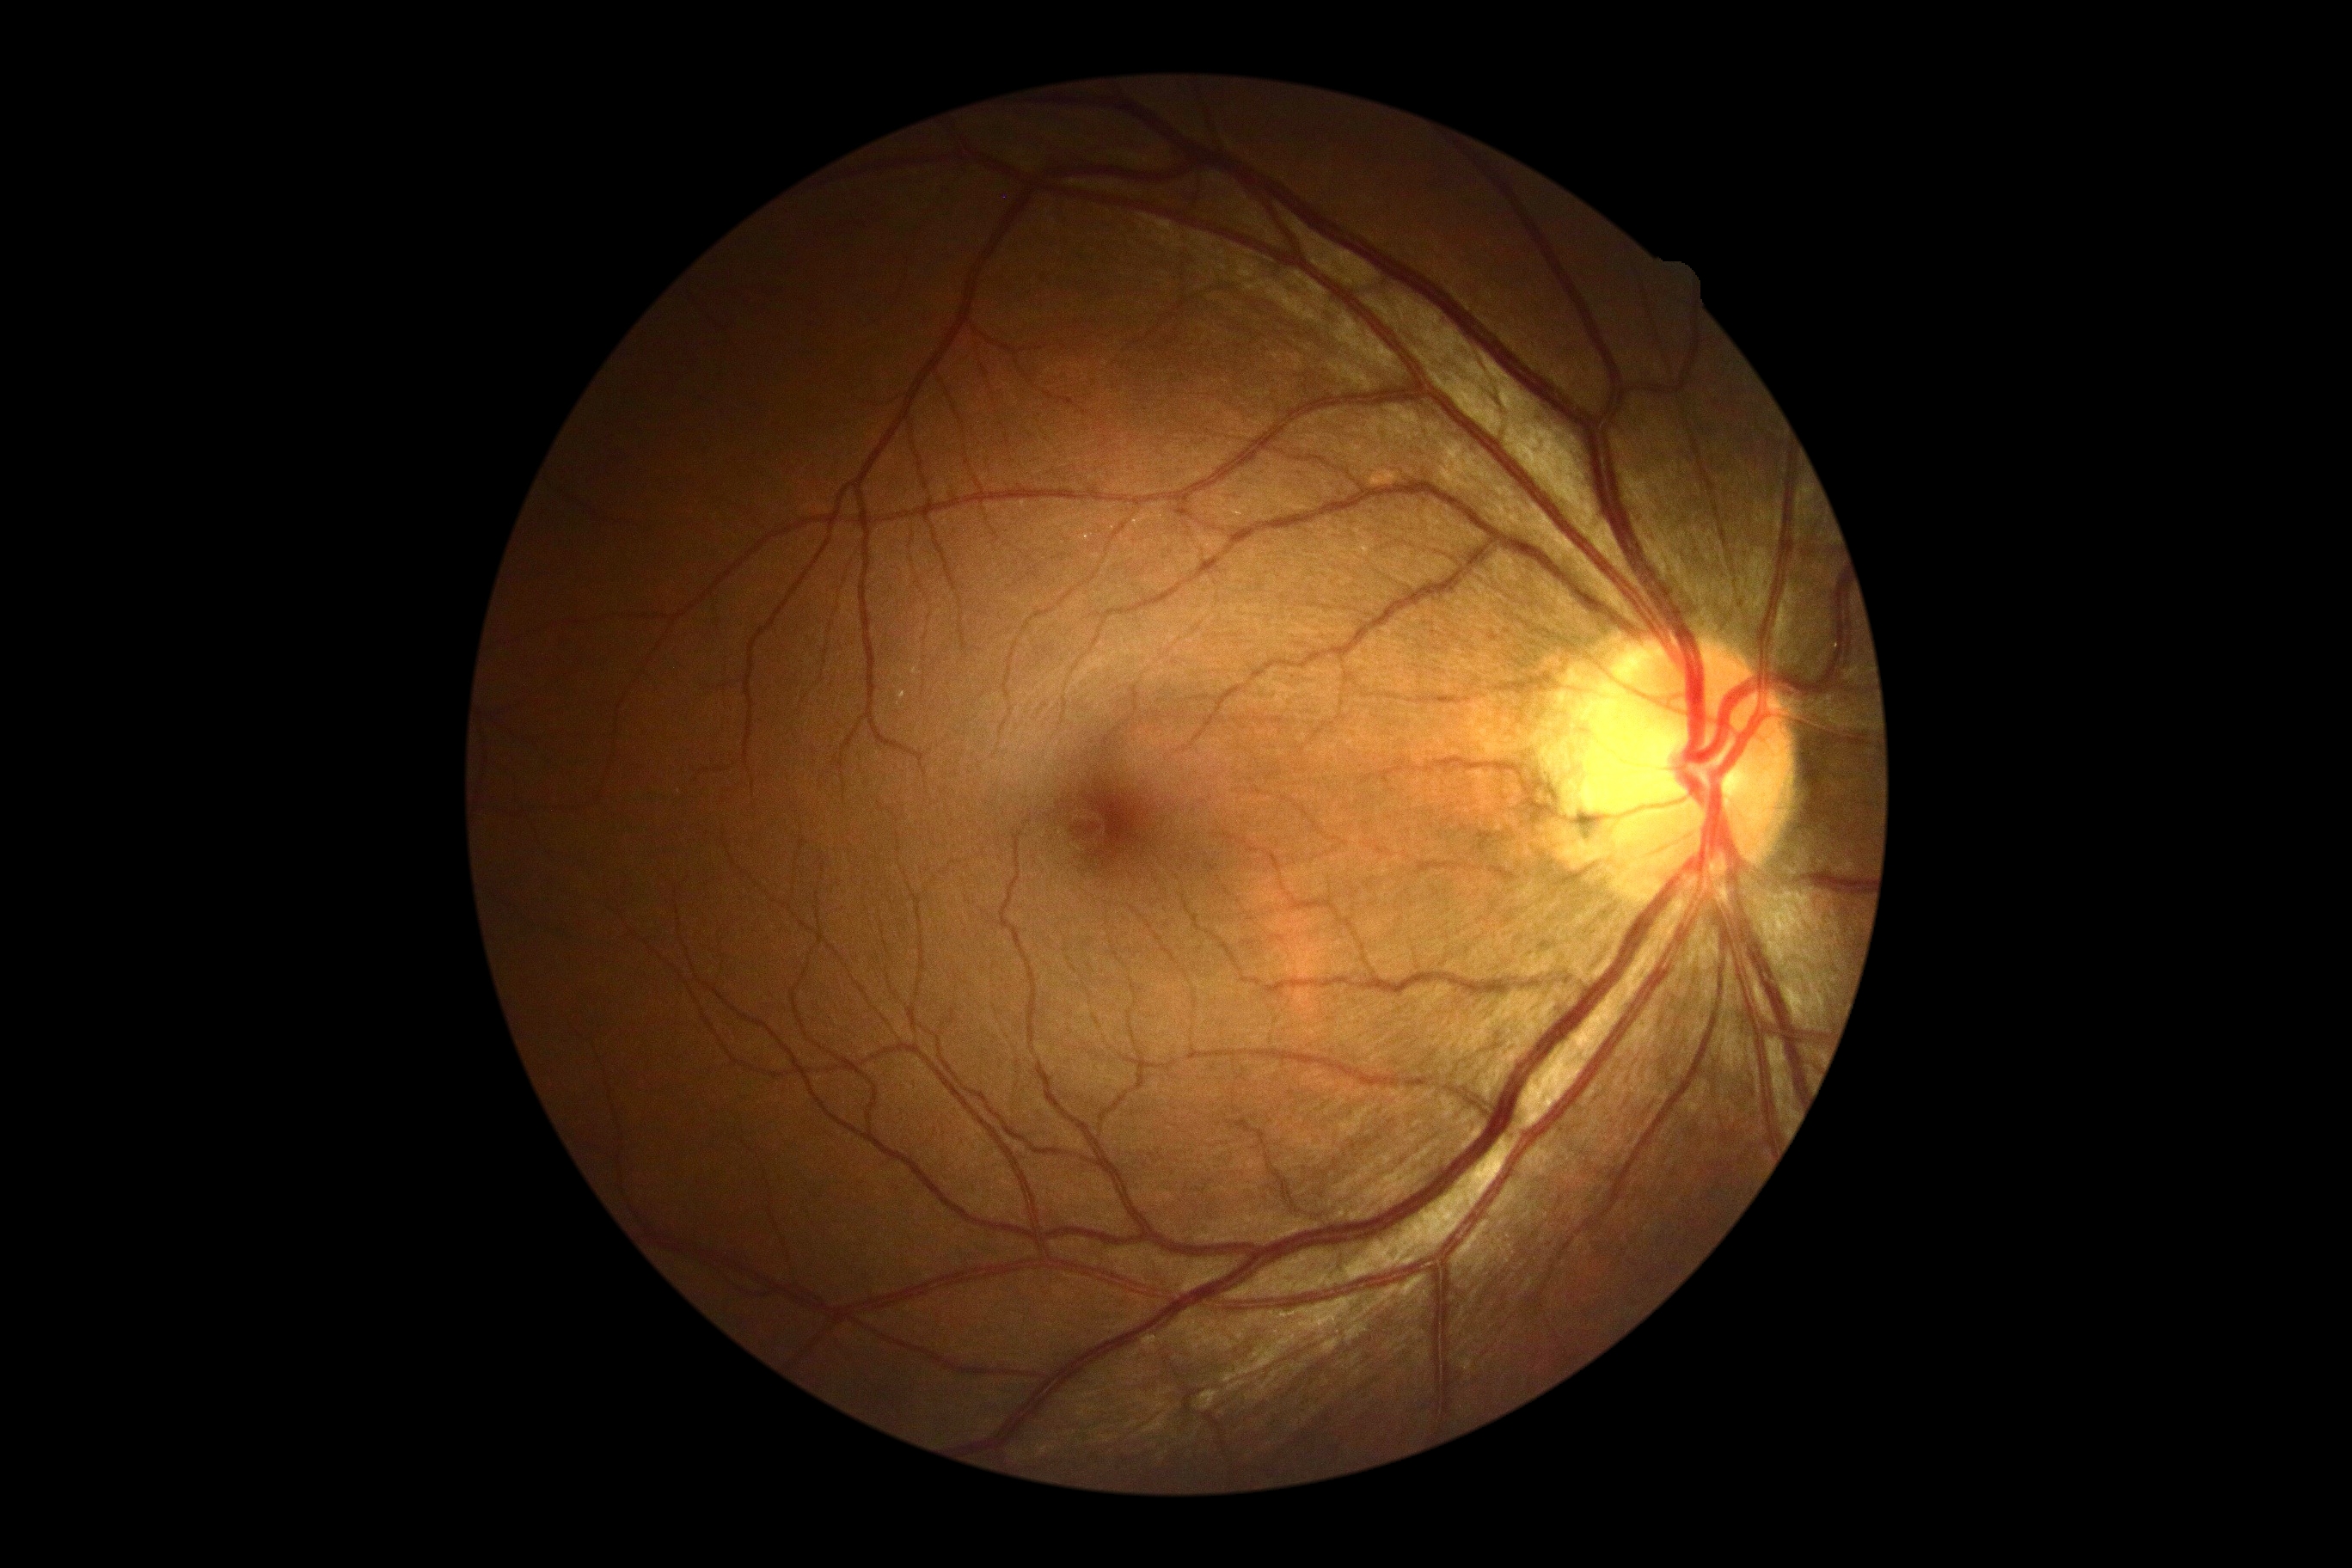 DR: 0.